CFP, 45° FOV, 1536x1152px:
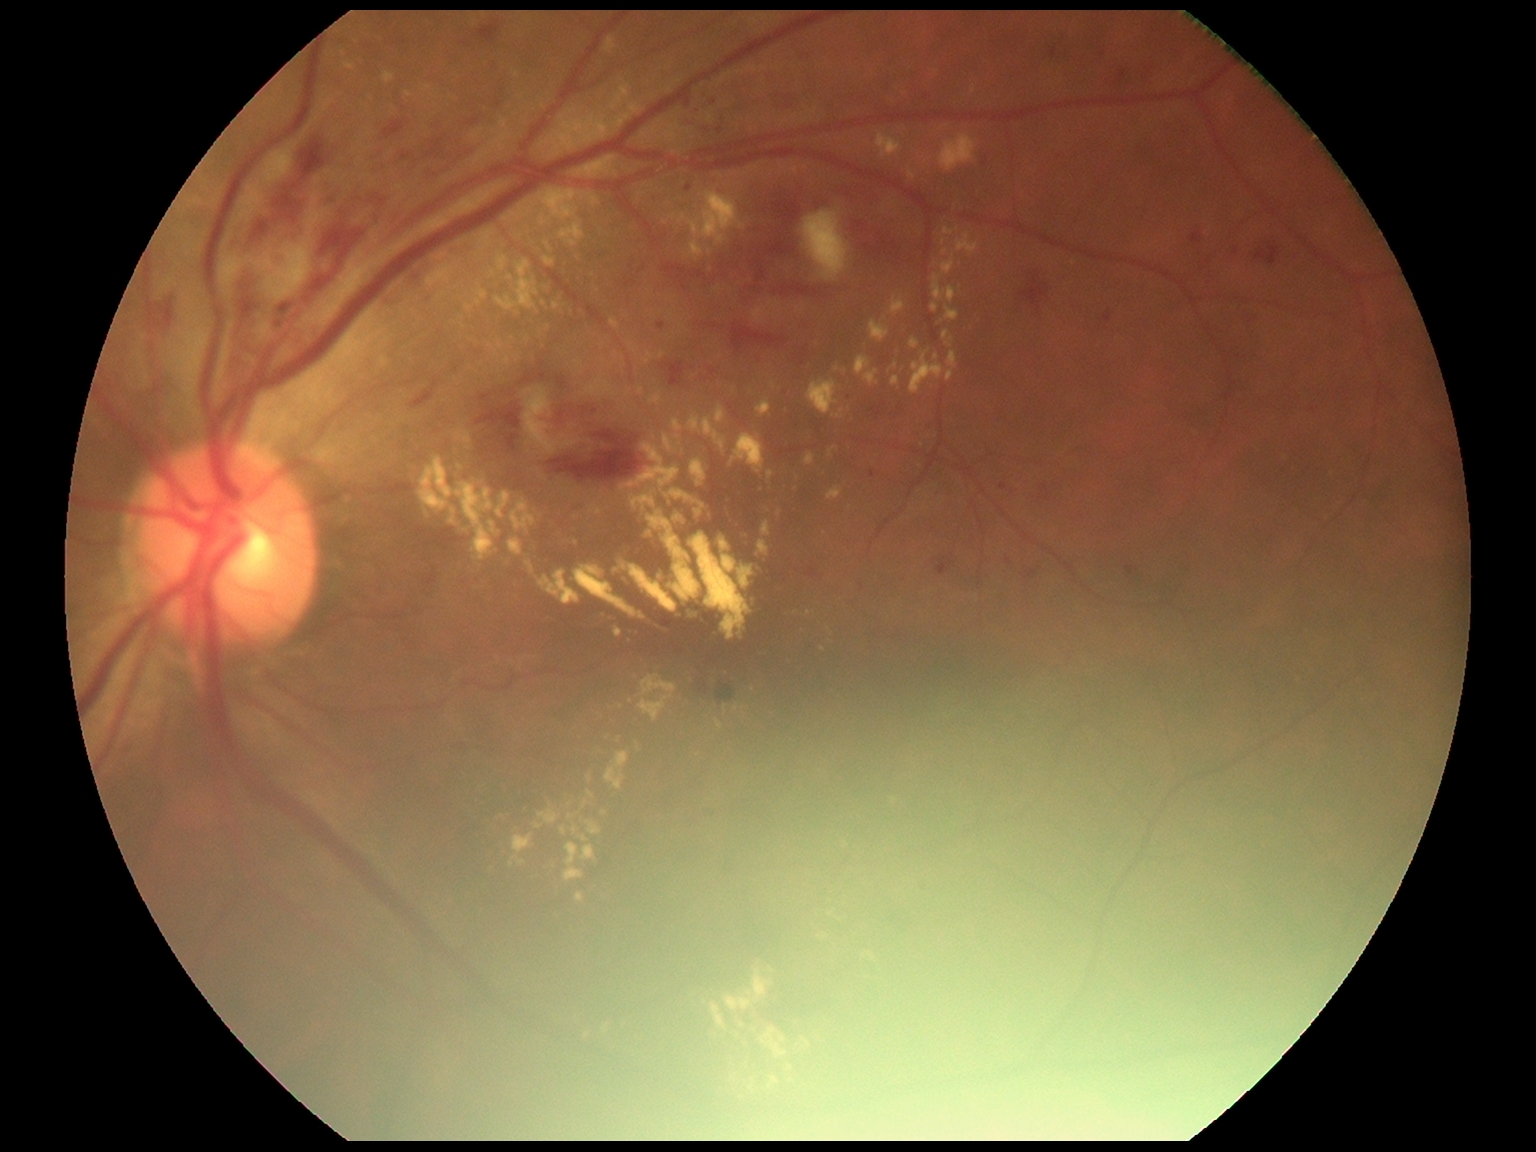

DR class@non-proliferative diabetic retinopathy; diabetic retinopathy (DR)@2.